Camera: Clarity RetCam 3 (130° FOV). Image size 640x480. Wide-field fundus photograph from neonatal ROP screening:
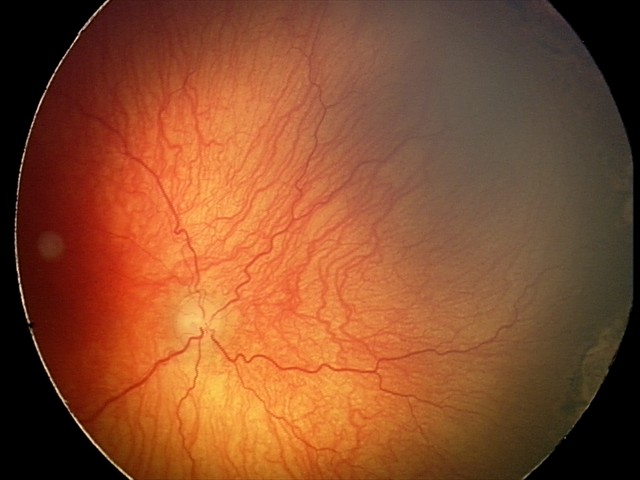

Impression: aggressive retinopathy of prematurity.